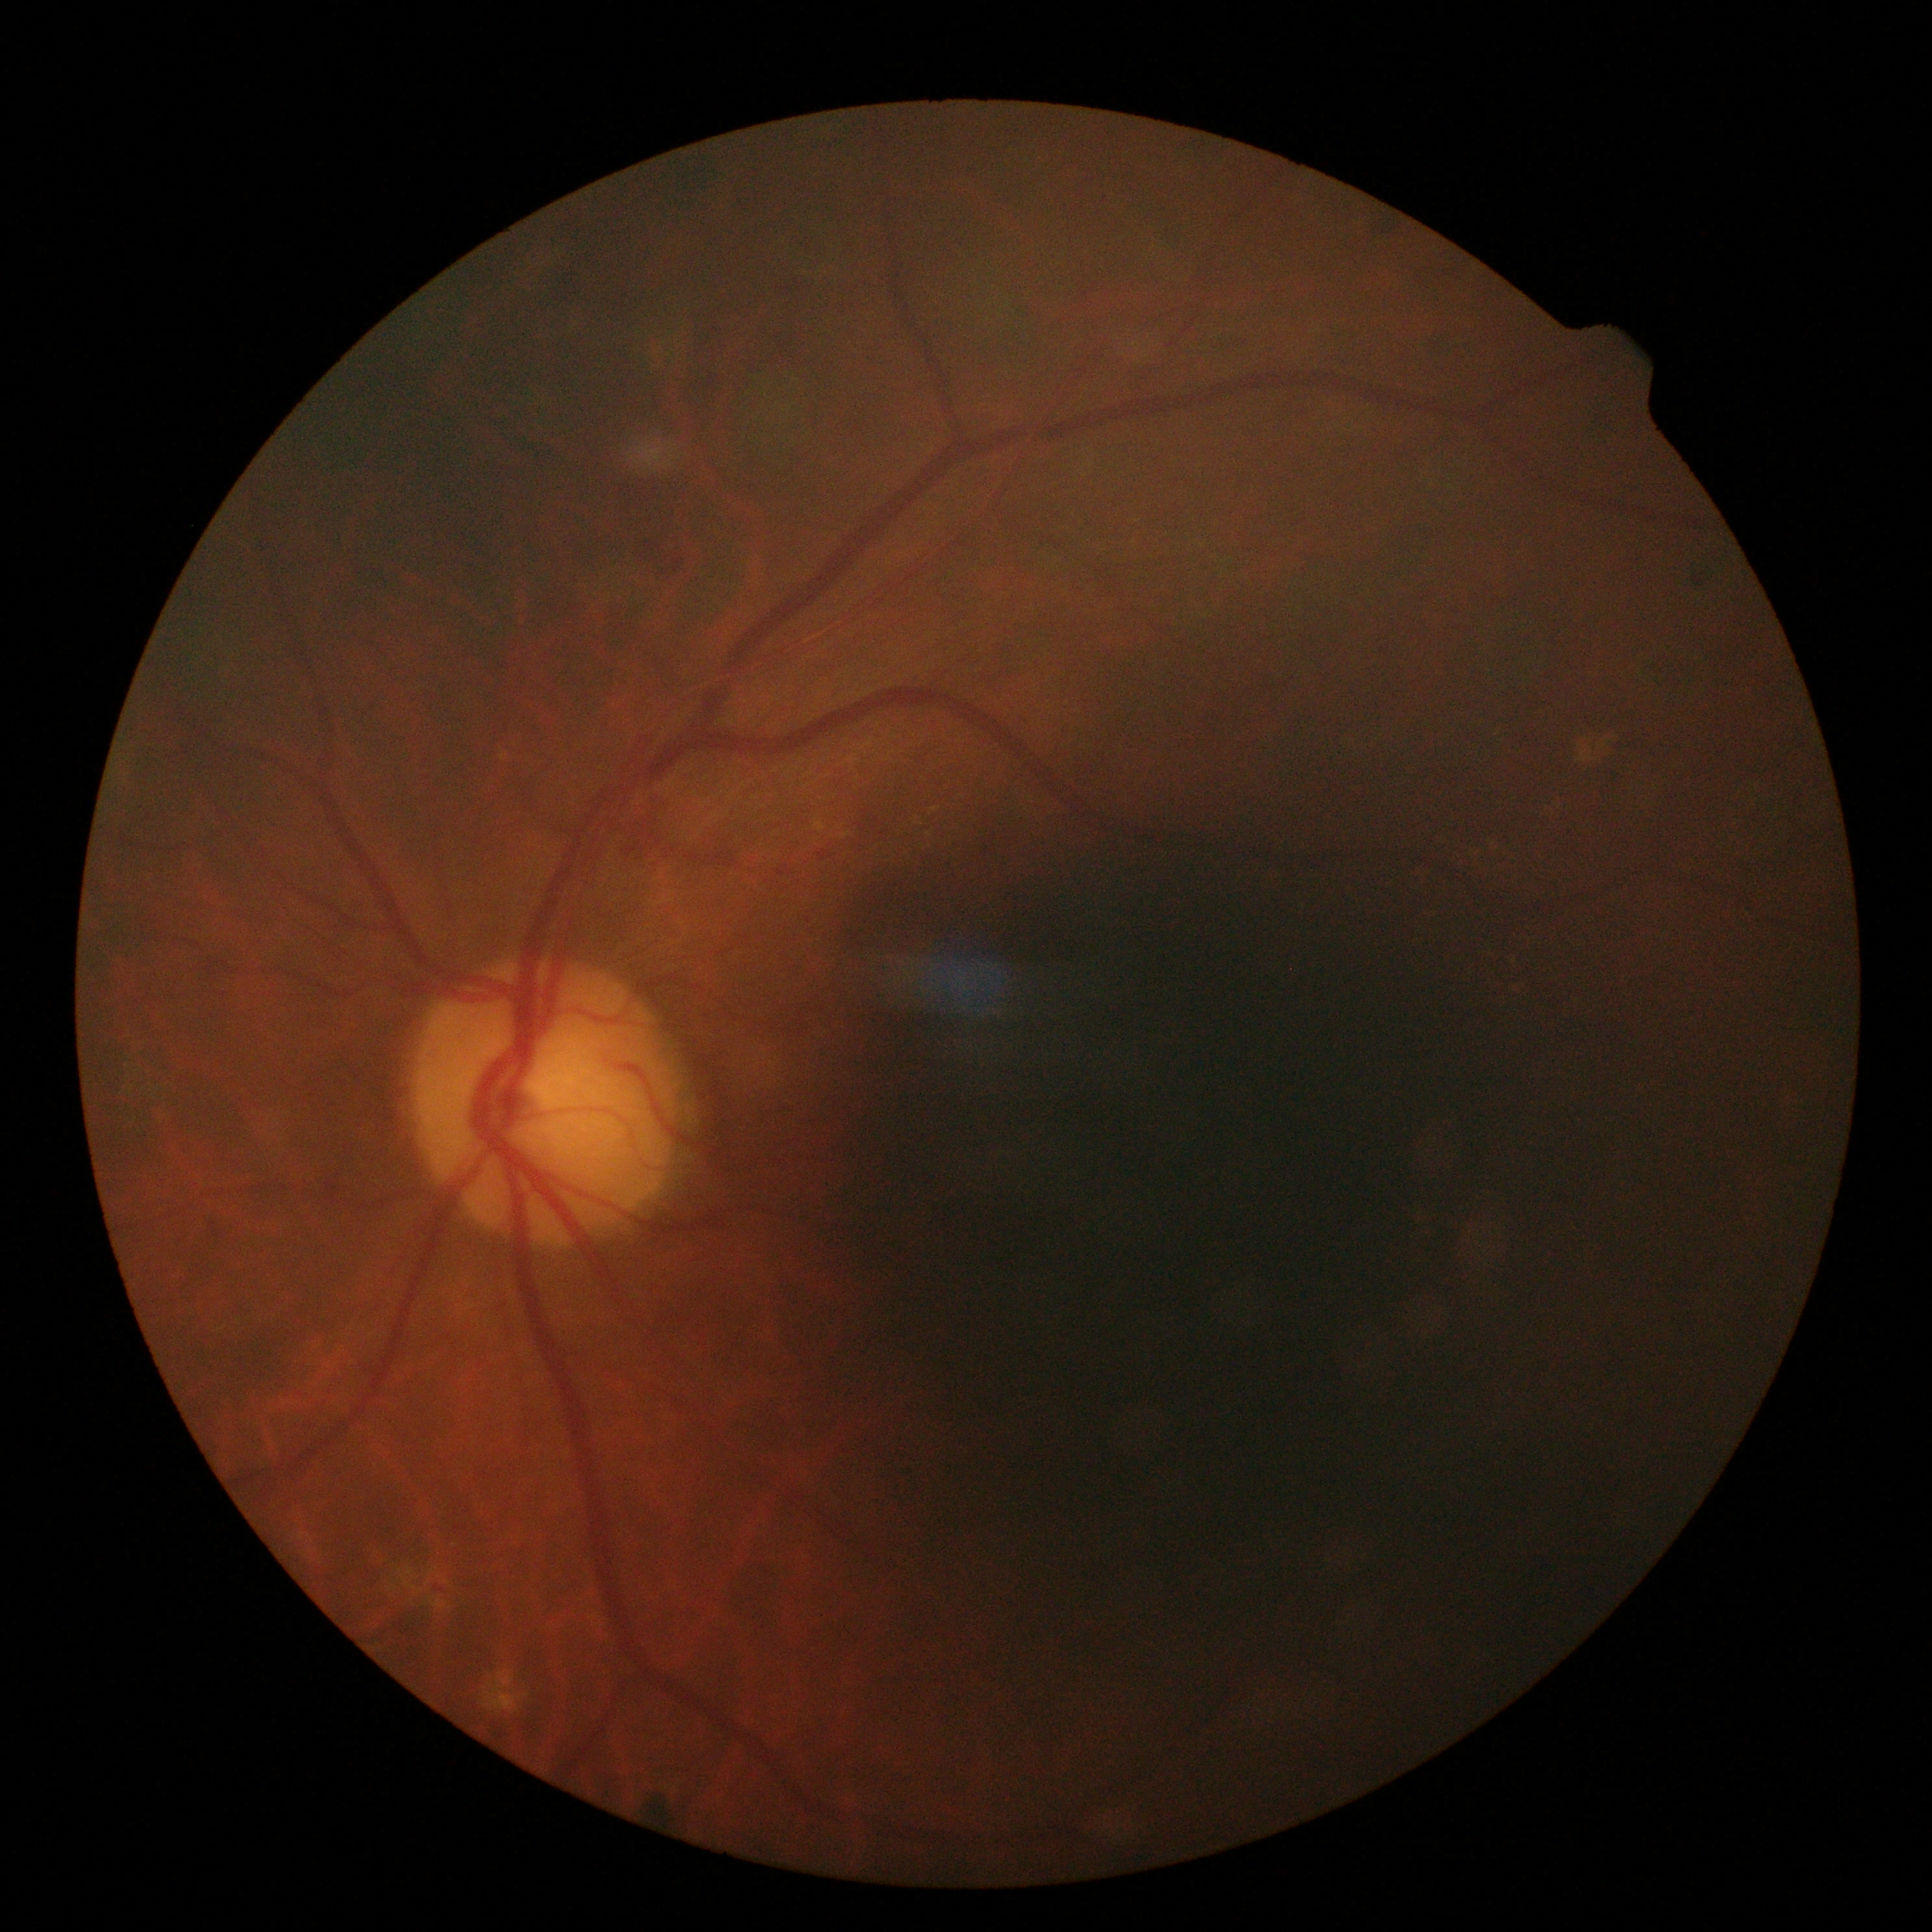 {"dr_grade": "2/4 — more than just microaneurysms but less than severe NPDR"}